848x848px — 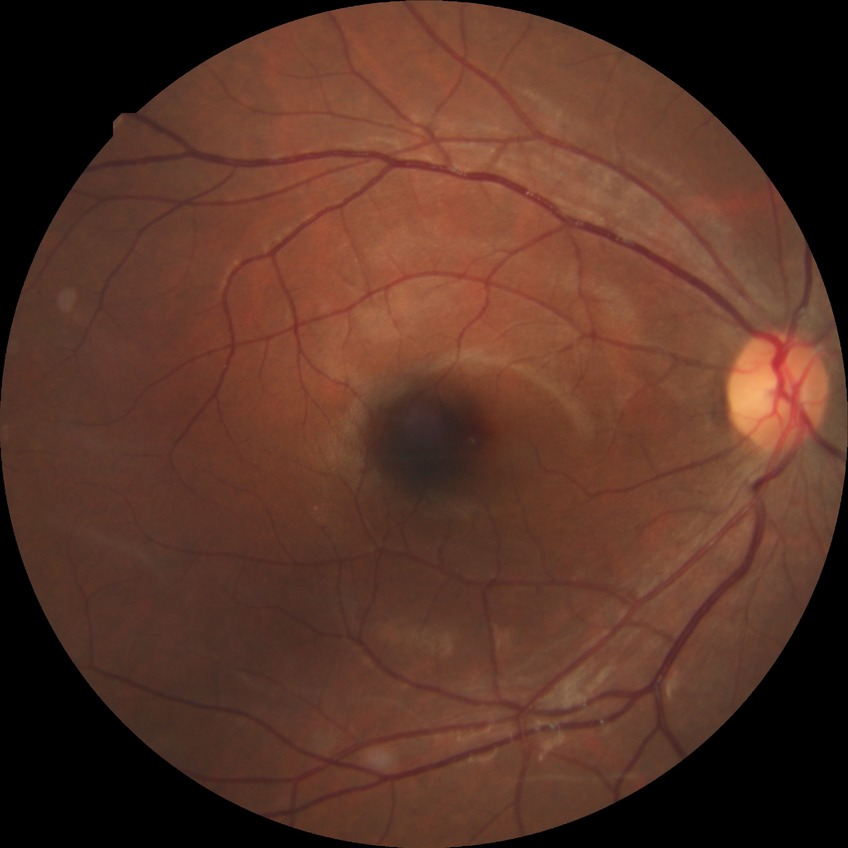

modified Davis grading: no diabetic retinopathy.